848x848 — 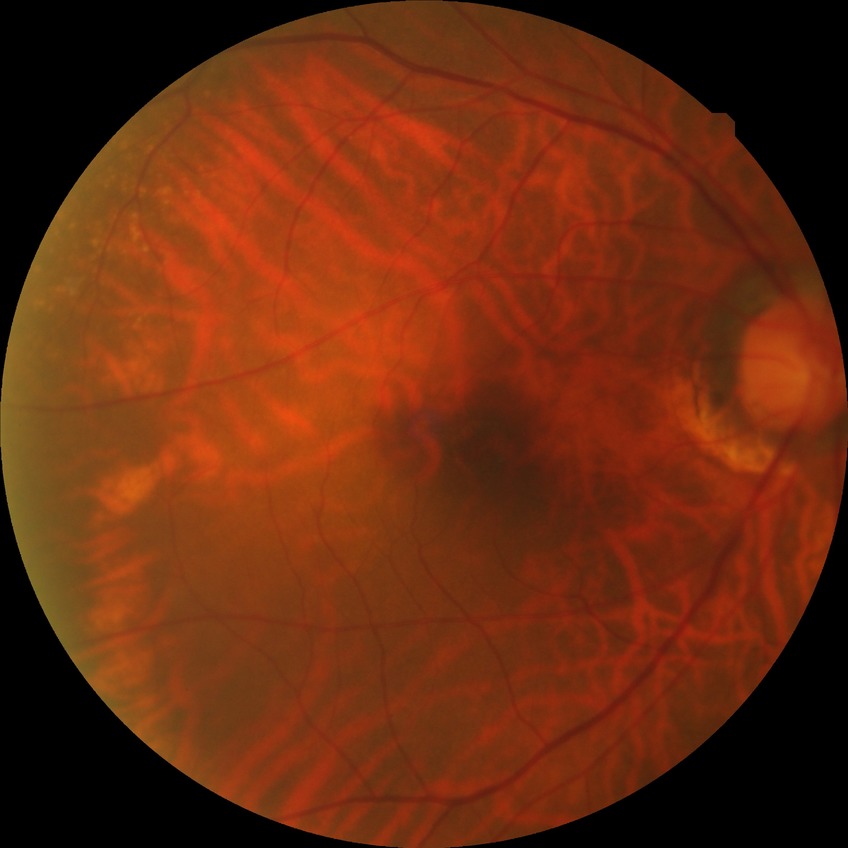
davis_grade: NDR (no diabetic retinopathy)